640 x 480 pixels; captured with the Clarity RetCam 3 (130° field of view); RetCam wide-field infant fundus image — 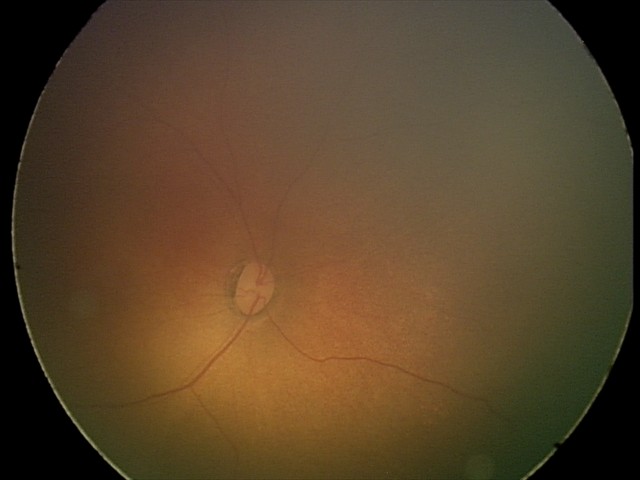

Physiological retinal appearance for postconceptual age.